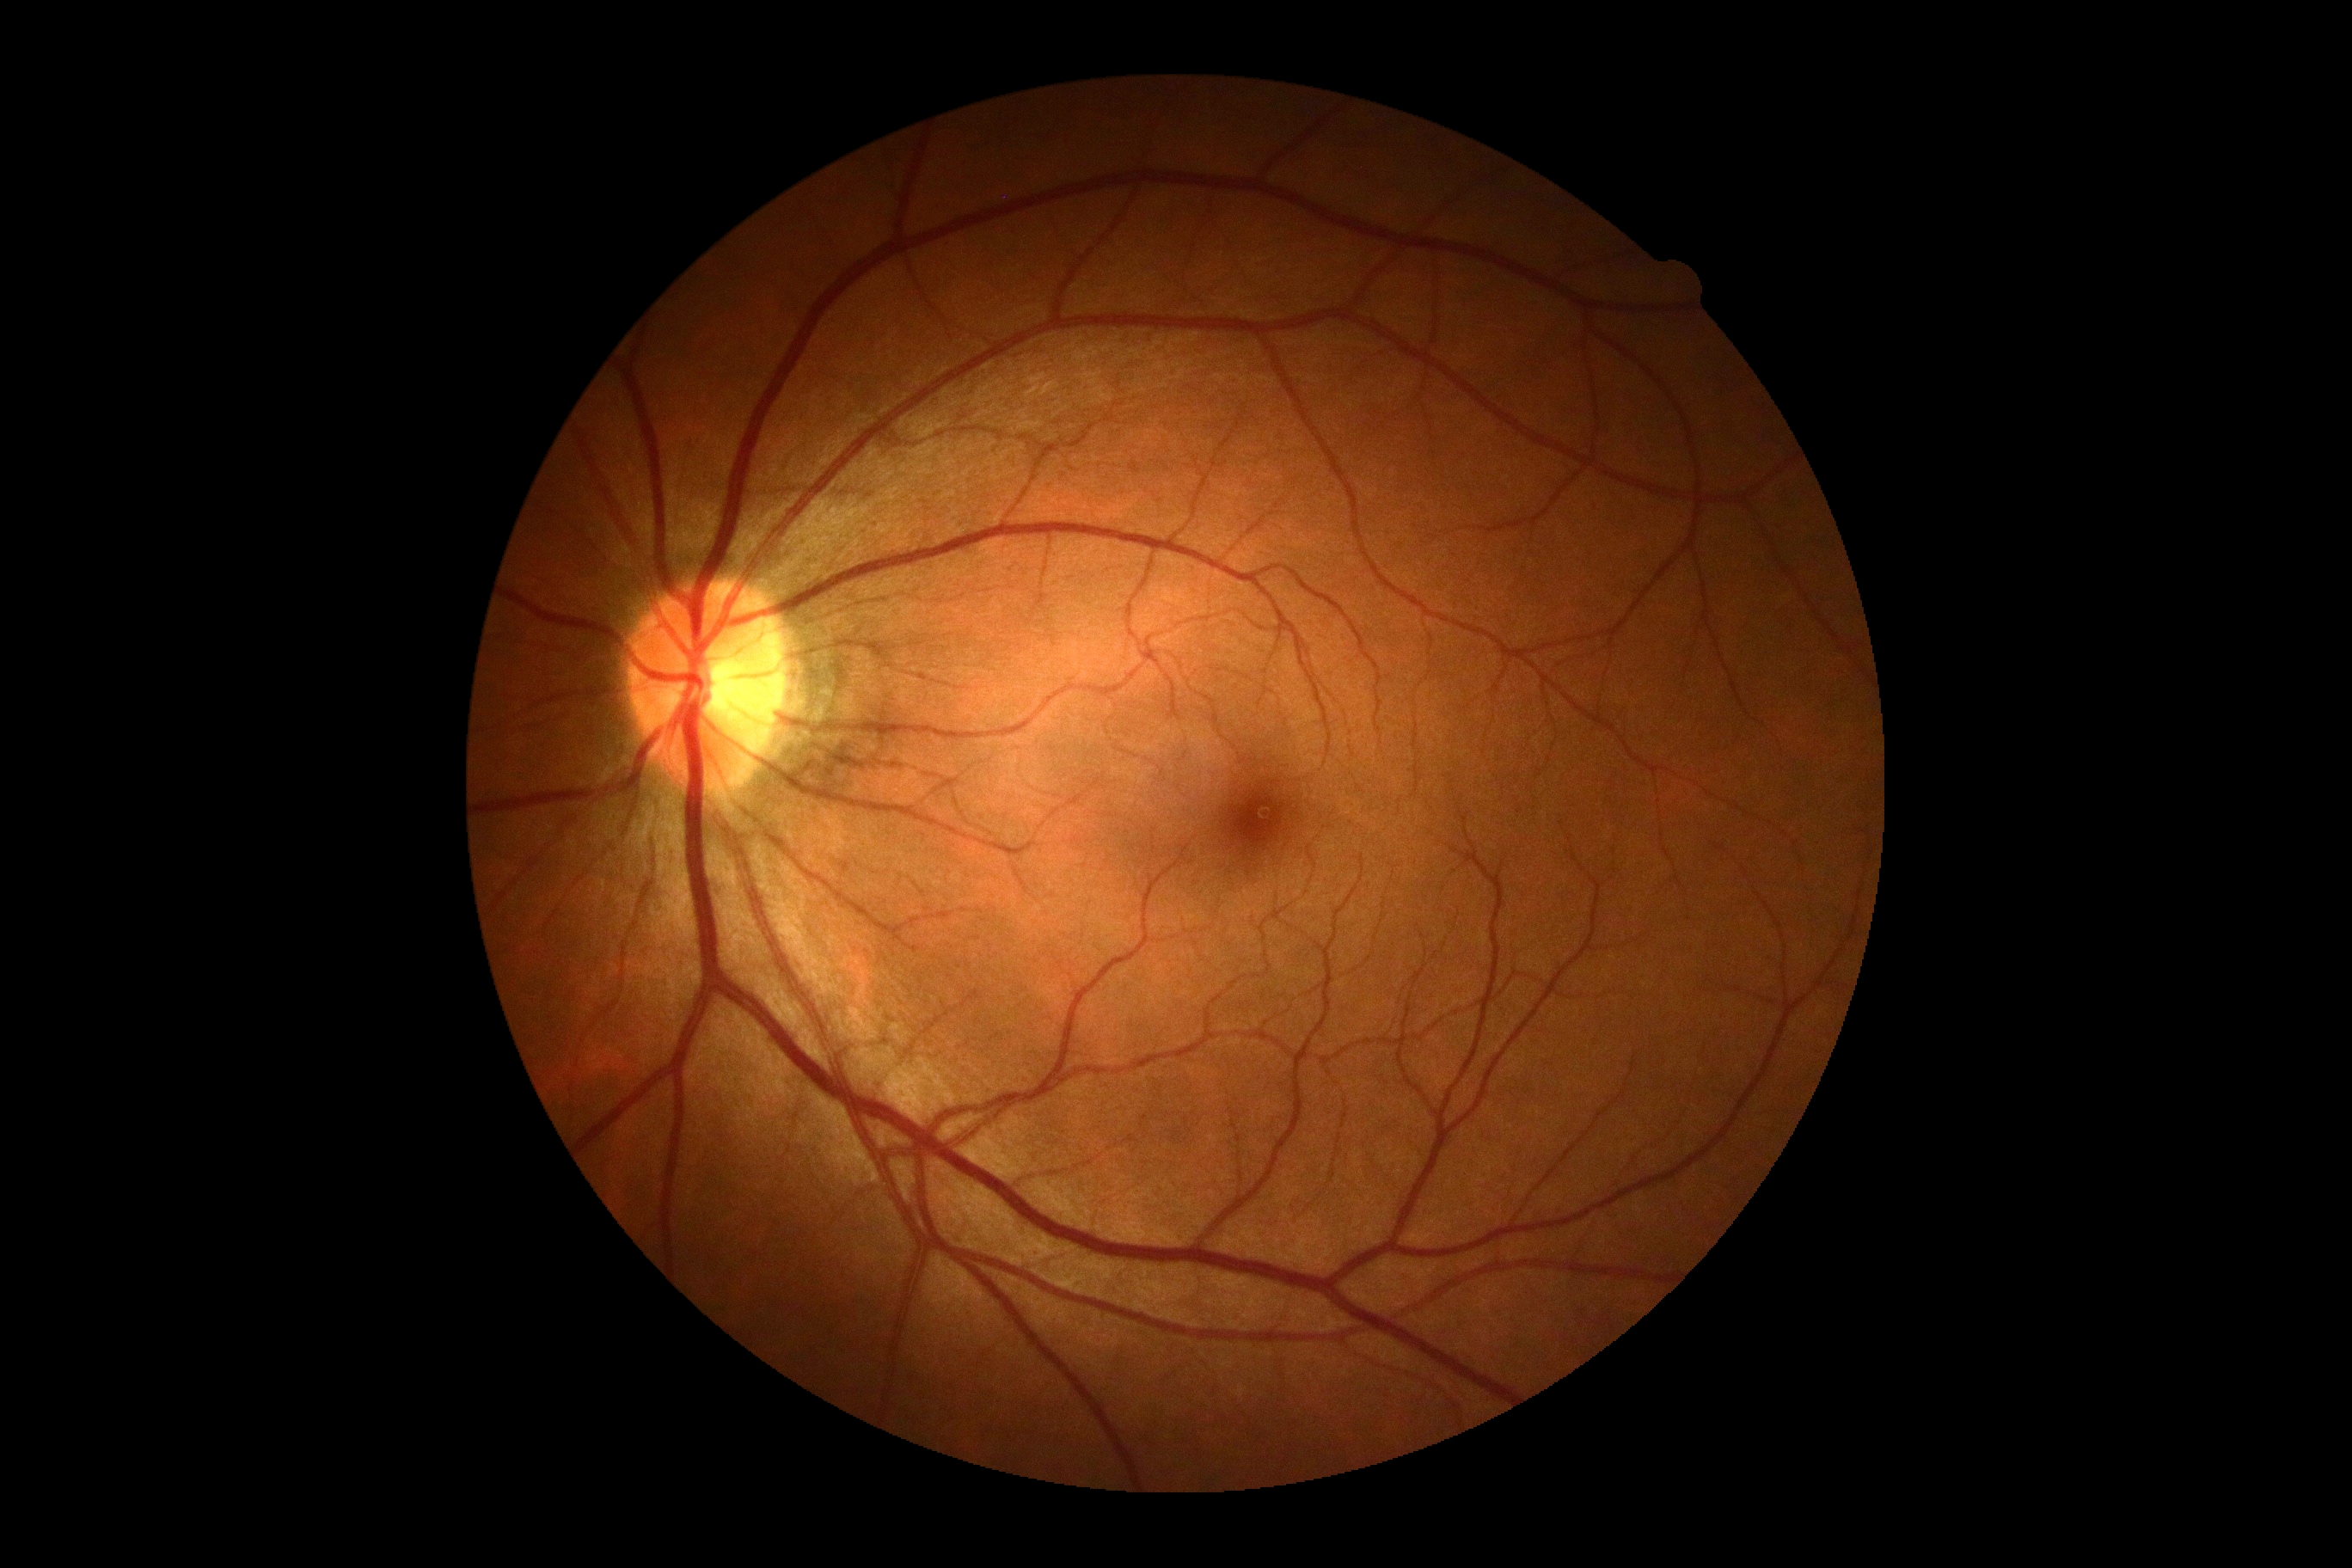 Annotations:
– DR impression — negative for DR
– diabetic retinopathy grade — 0/4